Color fundus photograph — 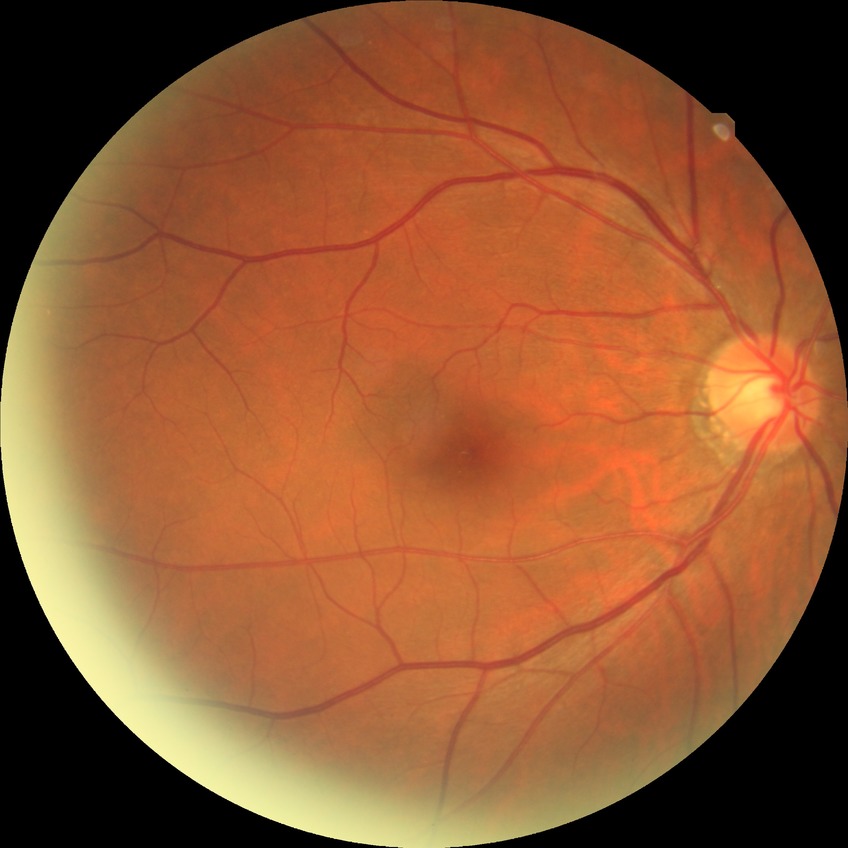 diabetic retinopathy (DR)=no diabetic retinopathy (NDR).